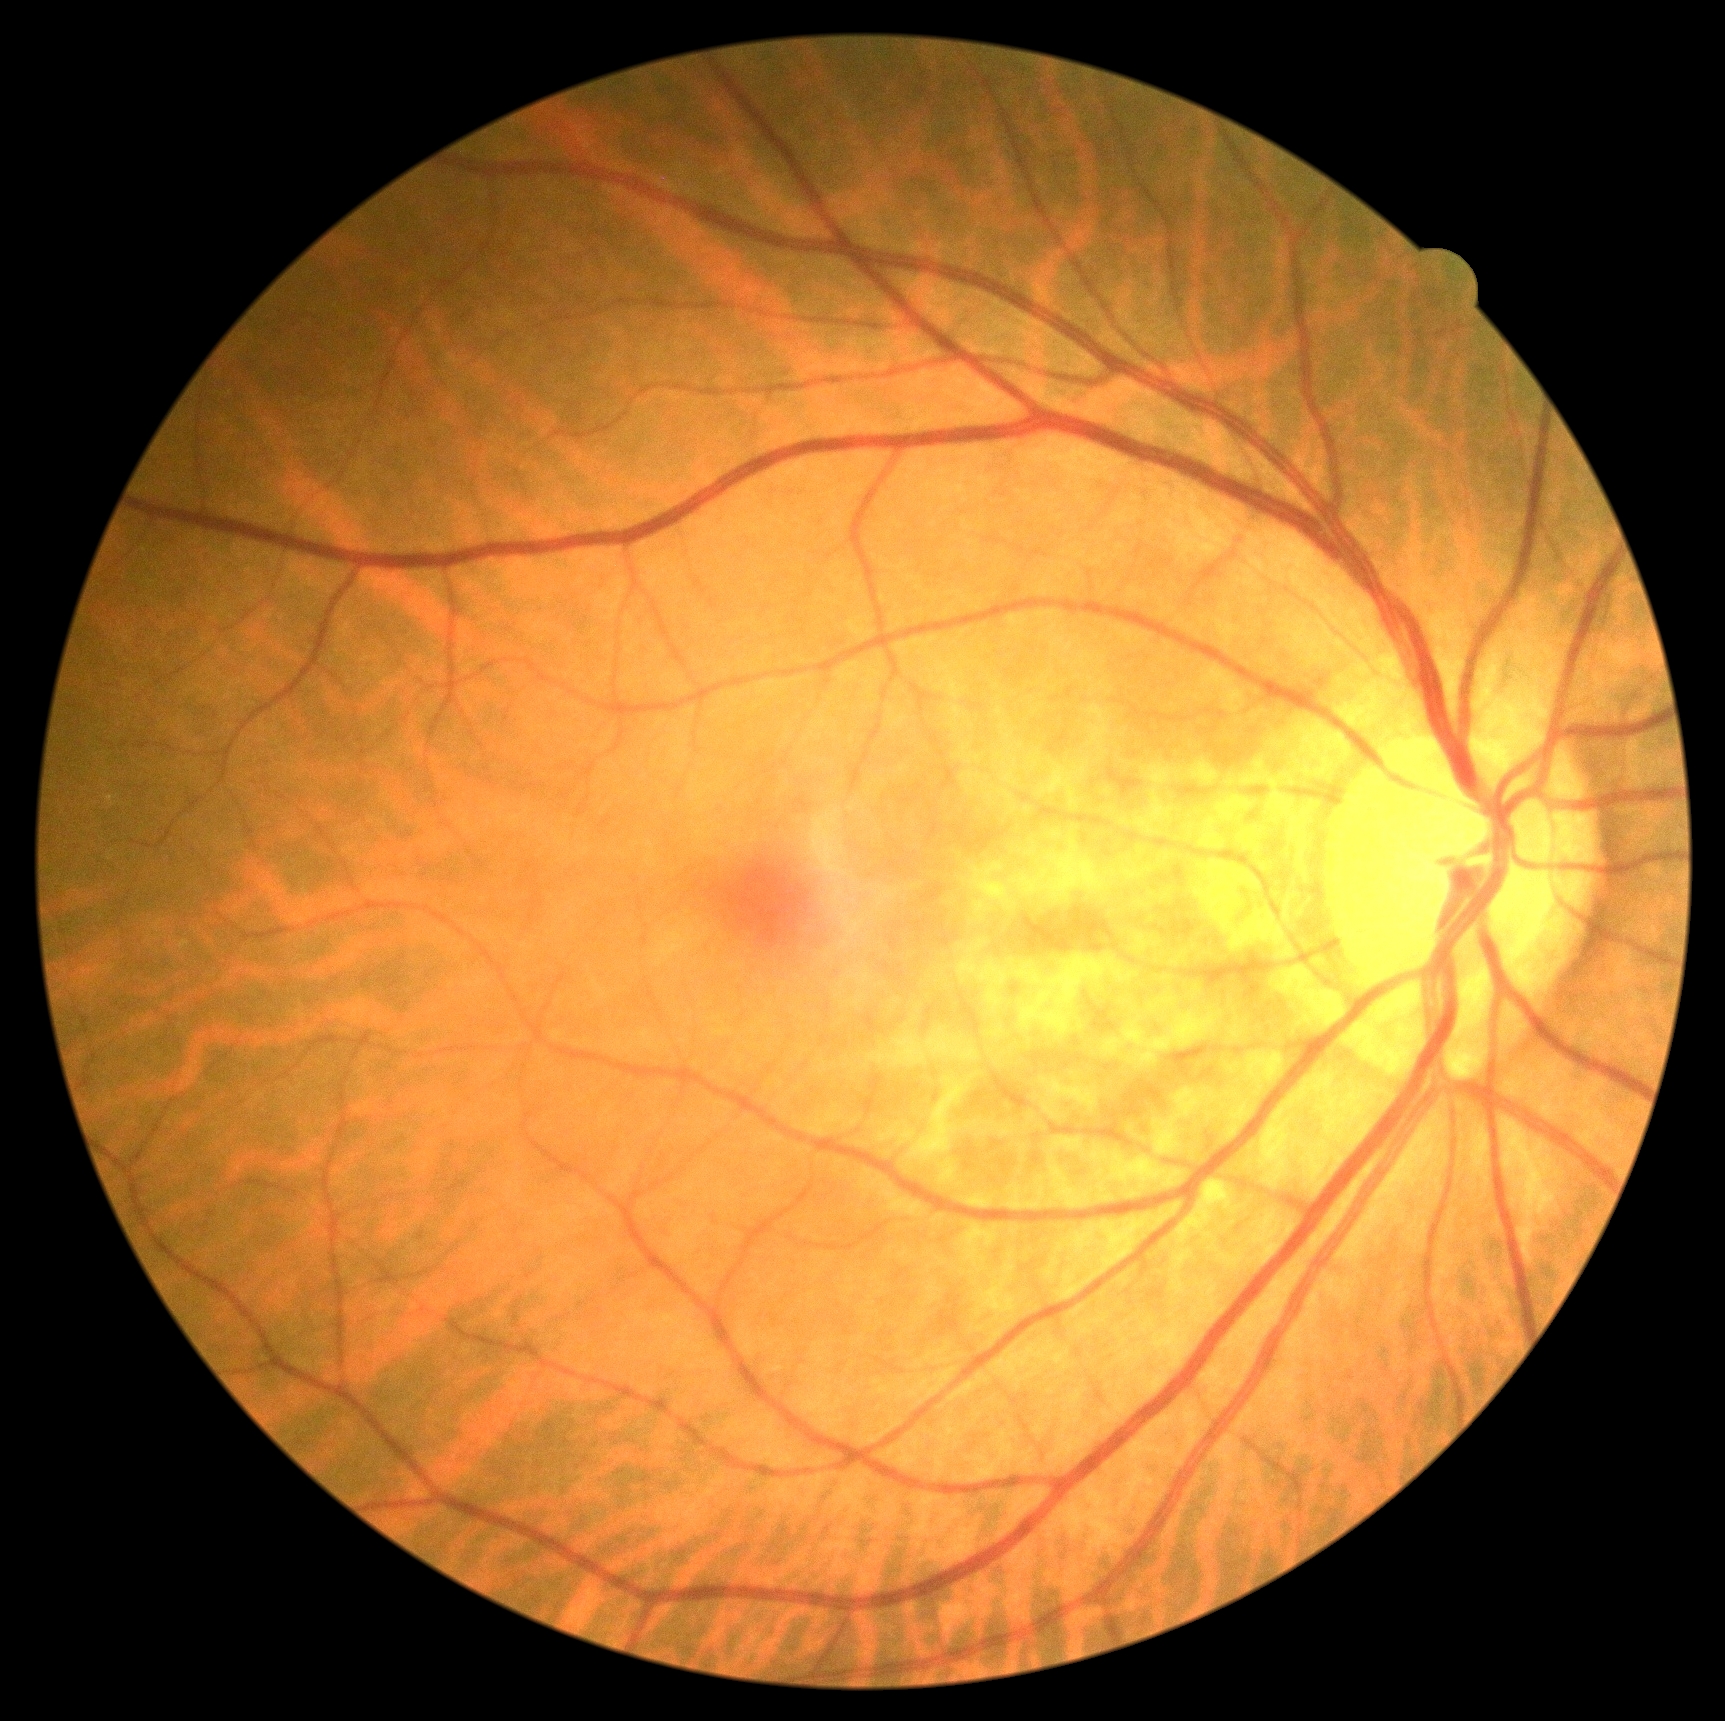 Annotations:
– diabetic retinopathy grade: 0